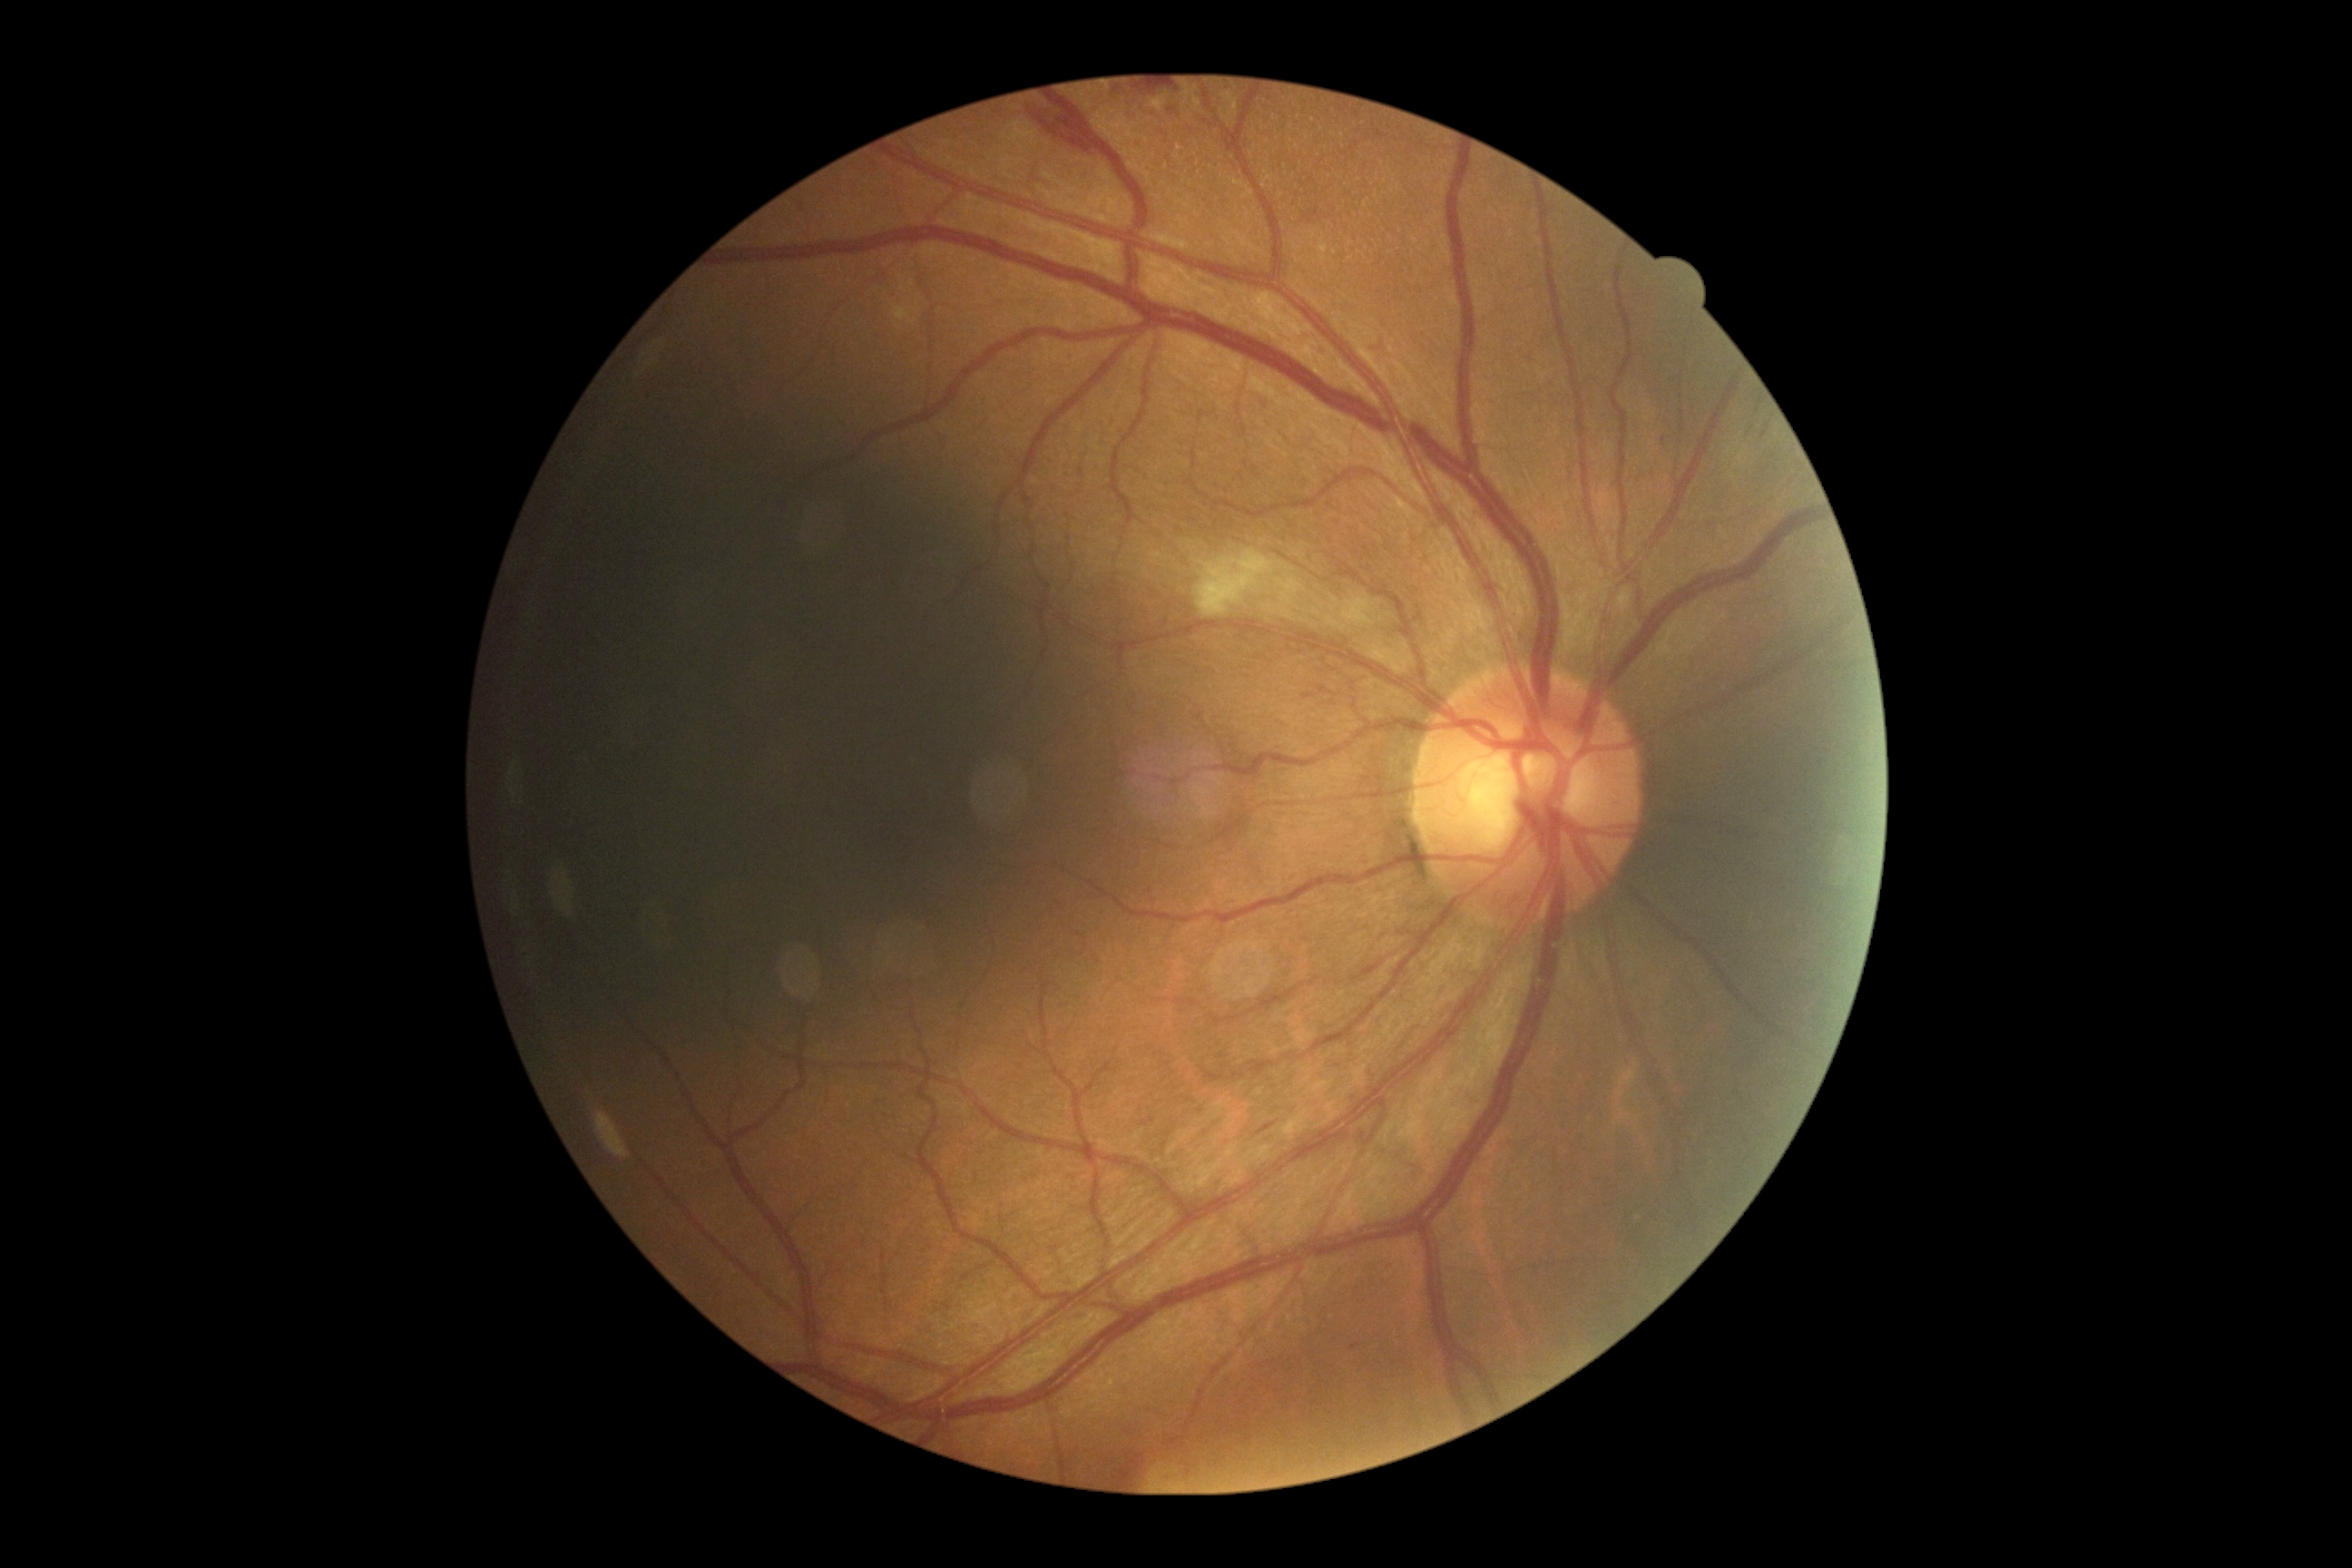 Diabetic retinopathy (DR) is moderate non-proliferative diabetic retinopathy (grade 2).